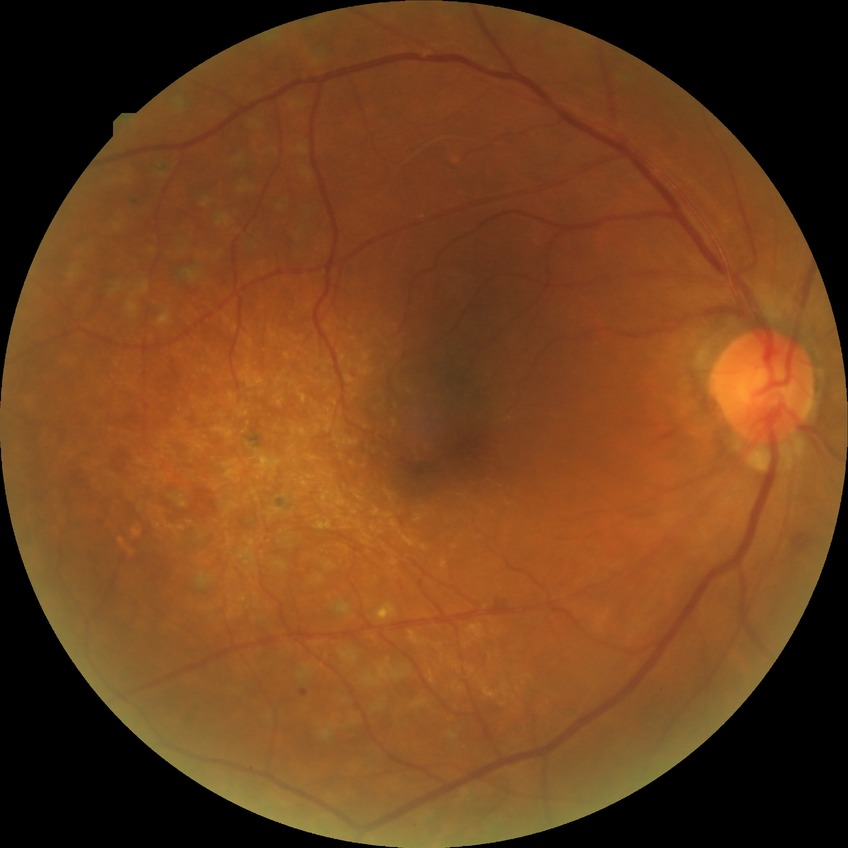 diabetic retinopathy (DR)=PDR (proliferative diabetic retinopathy).